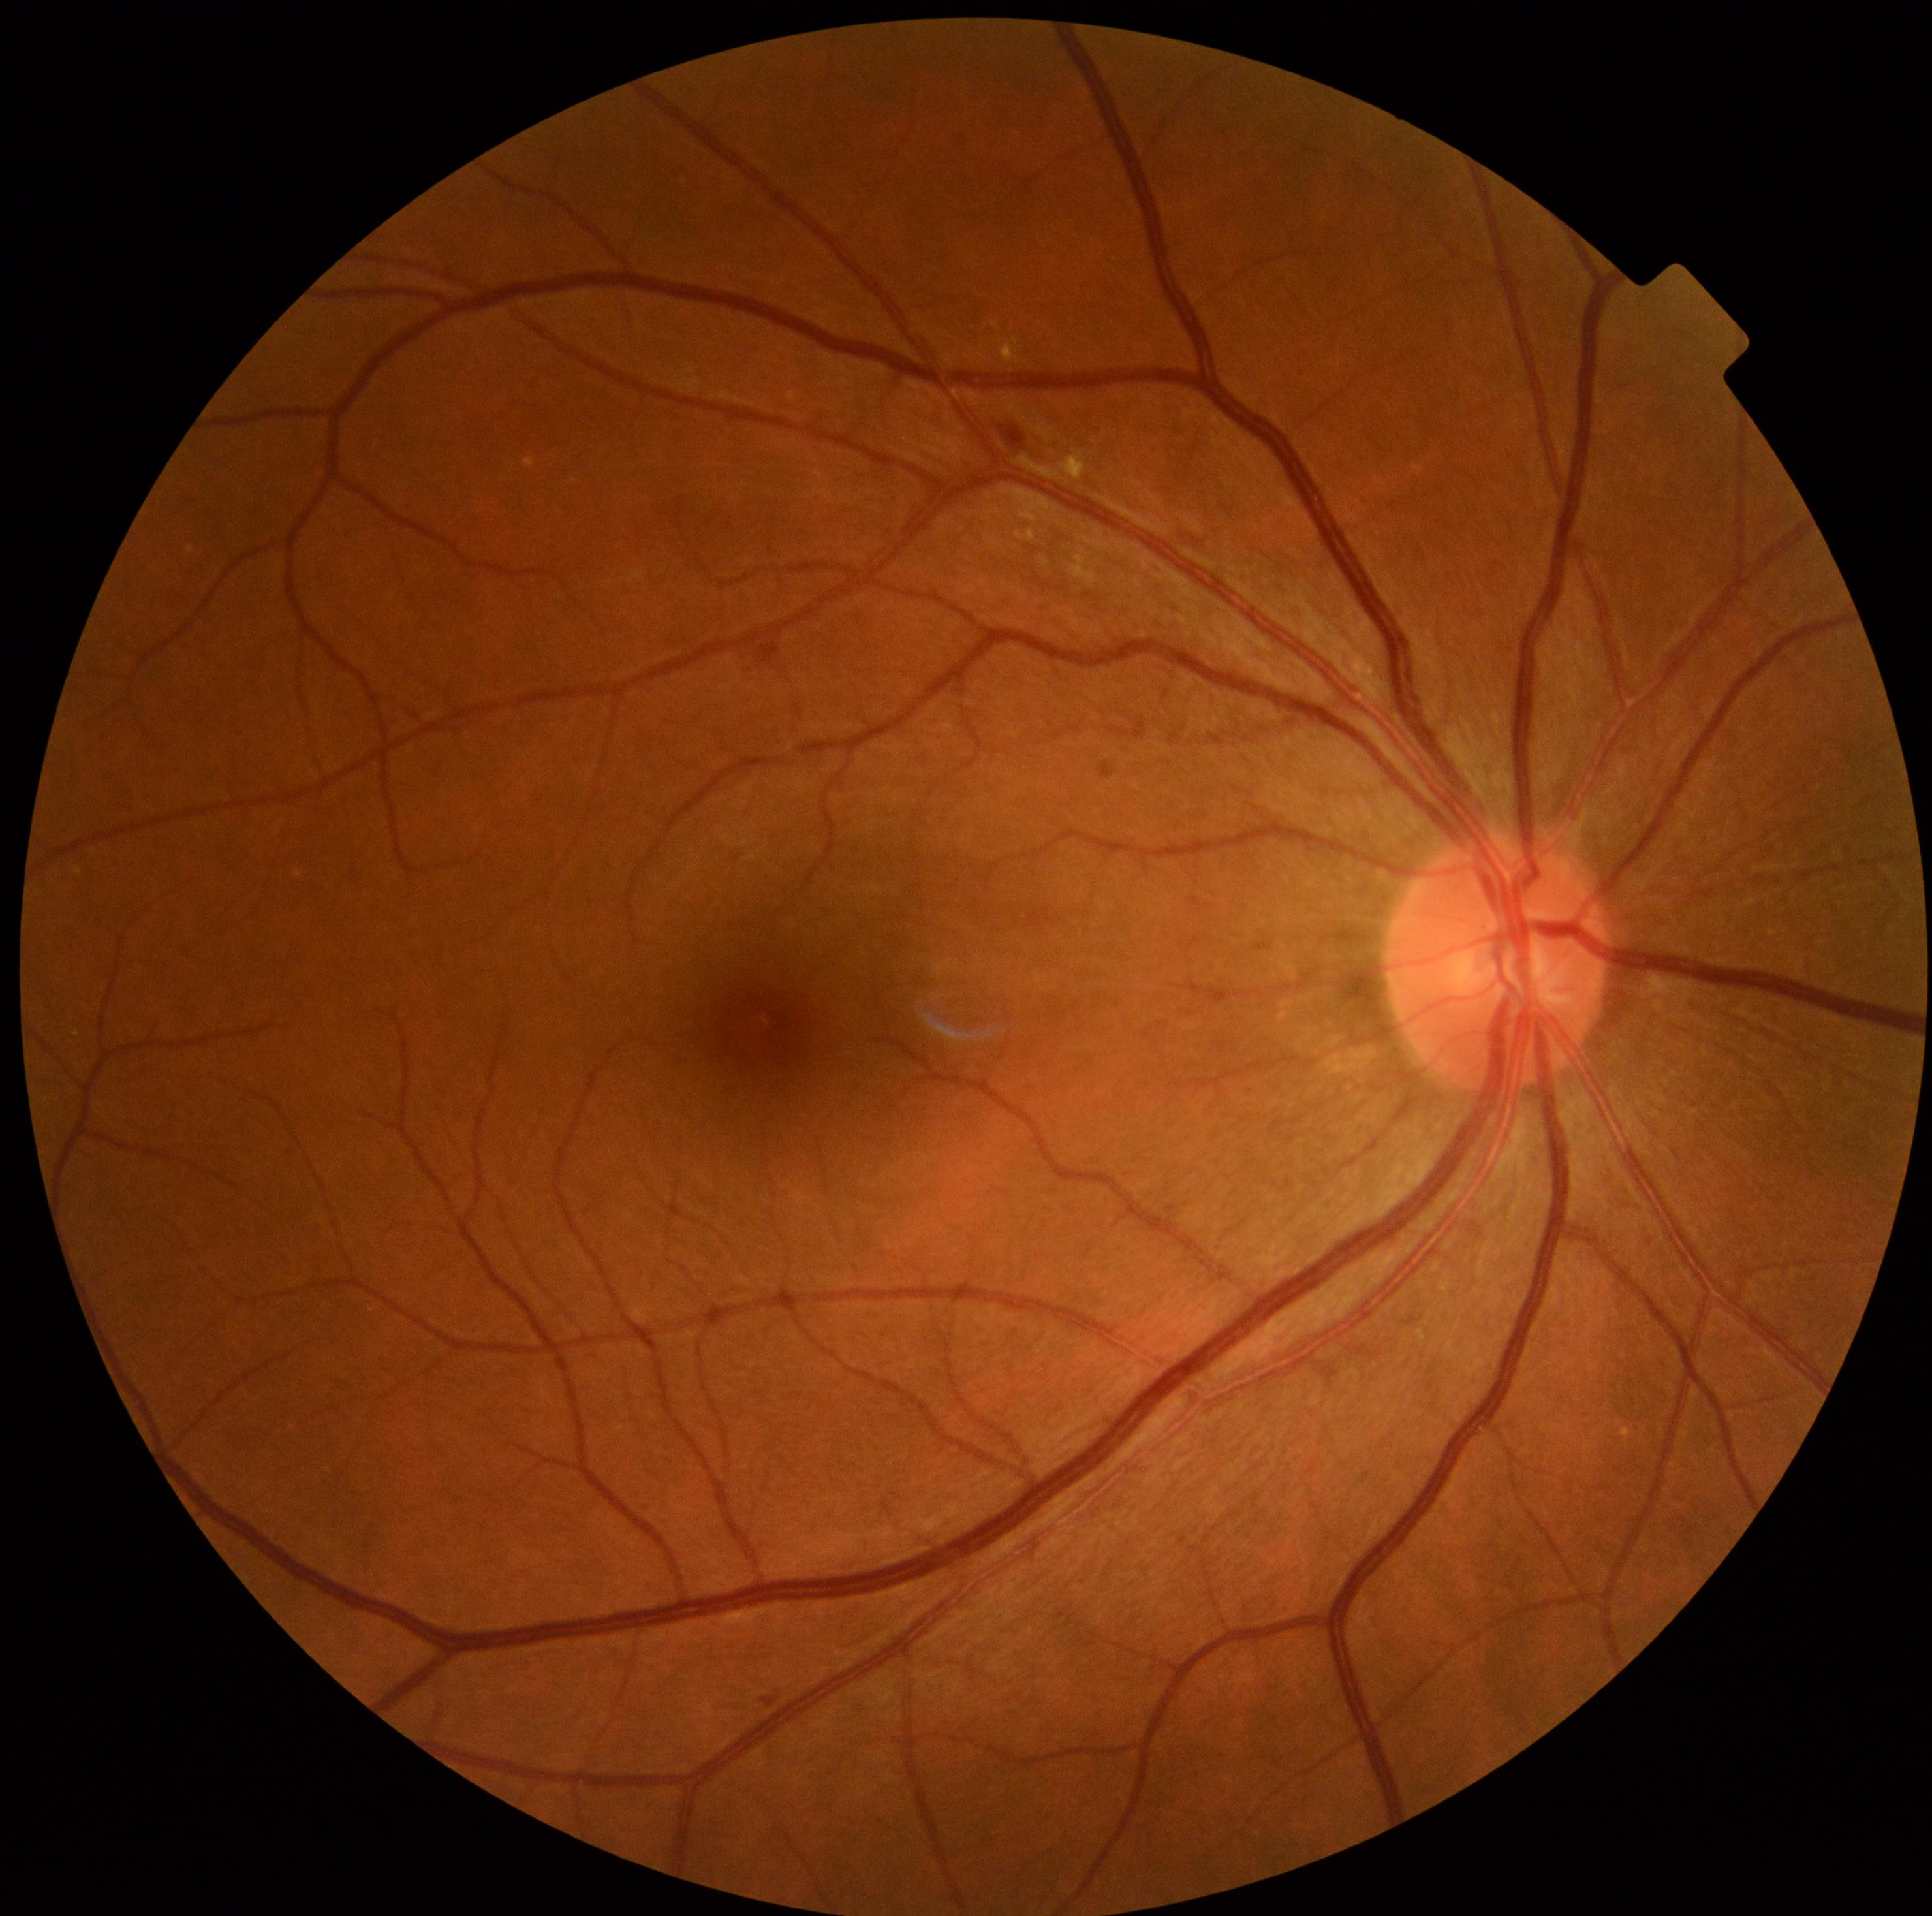 Retinopathy: moderate non-proliferative diabetic retinopathy (grade 2)
soft exudates: none
microaneurysms: none
hemorrhages: 999:427:1025:450; 763:1696:777:1708
hard exudates: 1070:554:1098:586; 525:458:535:469; 1041:558:1050:567; 1061:450:1087:480; 1020:510:1035:527; 1016:529:1037:542; 1002:339:1020:363